FOV: 45 degrees. 848x848. Nonmydriatic. Acquired with a NIDEK AFC-230. Color fundus image.
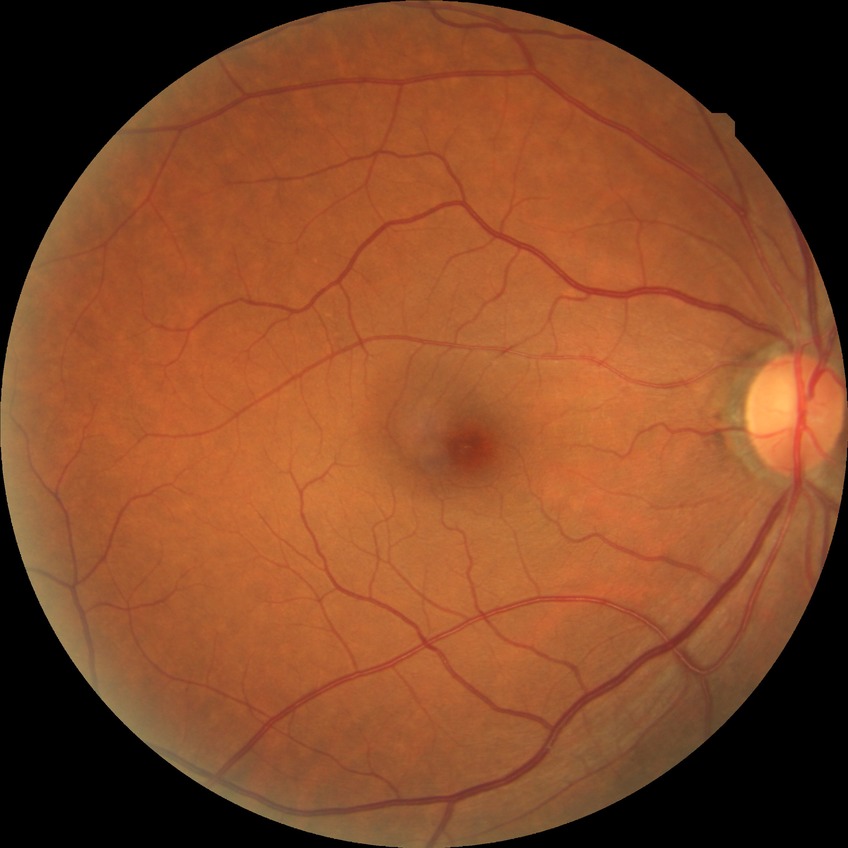 Assessment:
* retinopathy grade — no diabetic retinopathy